Fundus photo — 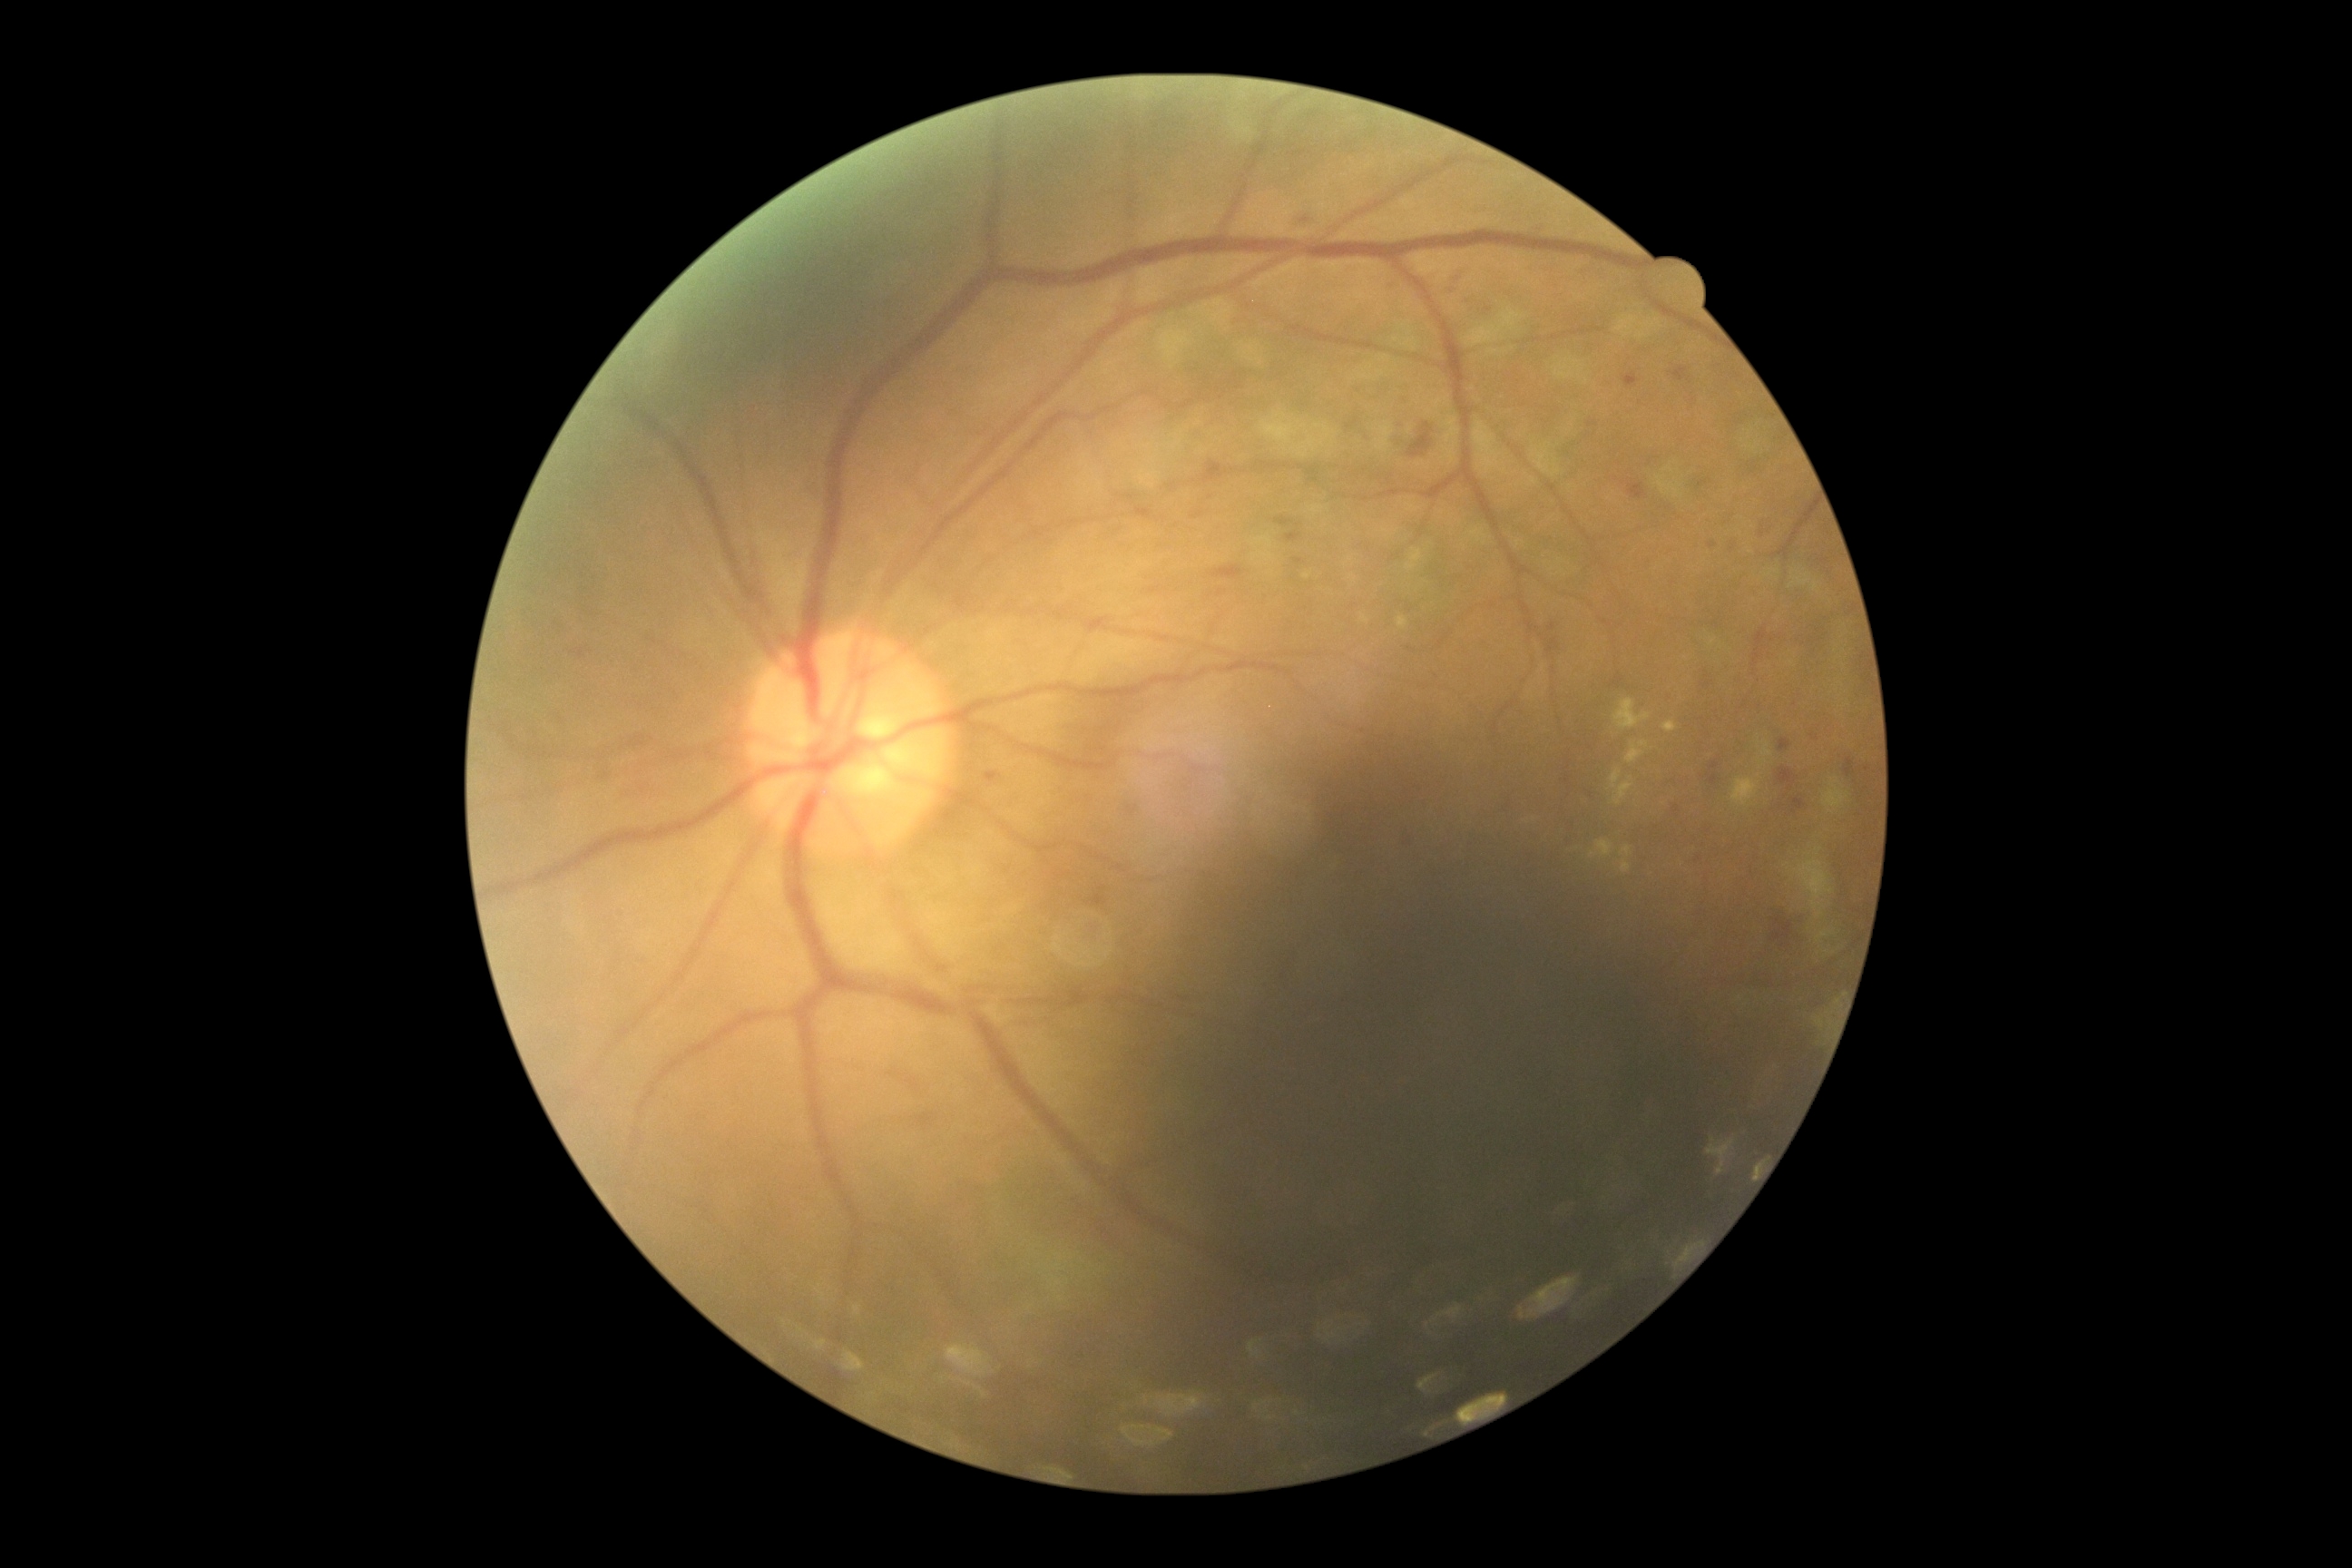 Retinopathy grade is 2 (moderate NPDR) — more than just microaneurysms but less than severe NPDR.